Wide-field fundus image from infant ROP screening.
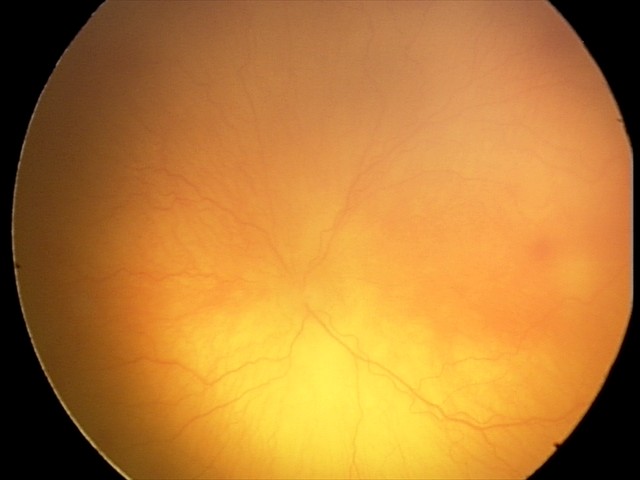

Series diagnosed as aggressive retinopathy of prematurity — rapidly progressive severe ROP with prominent plus disease, often without classic stage progression.